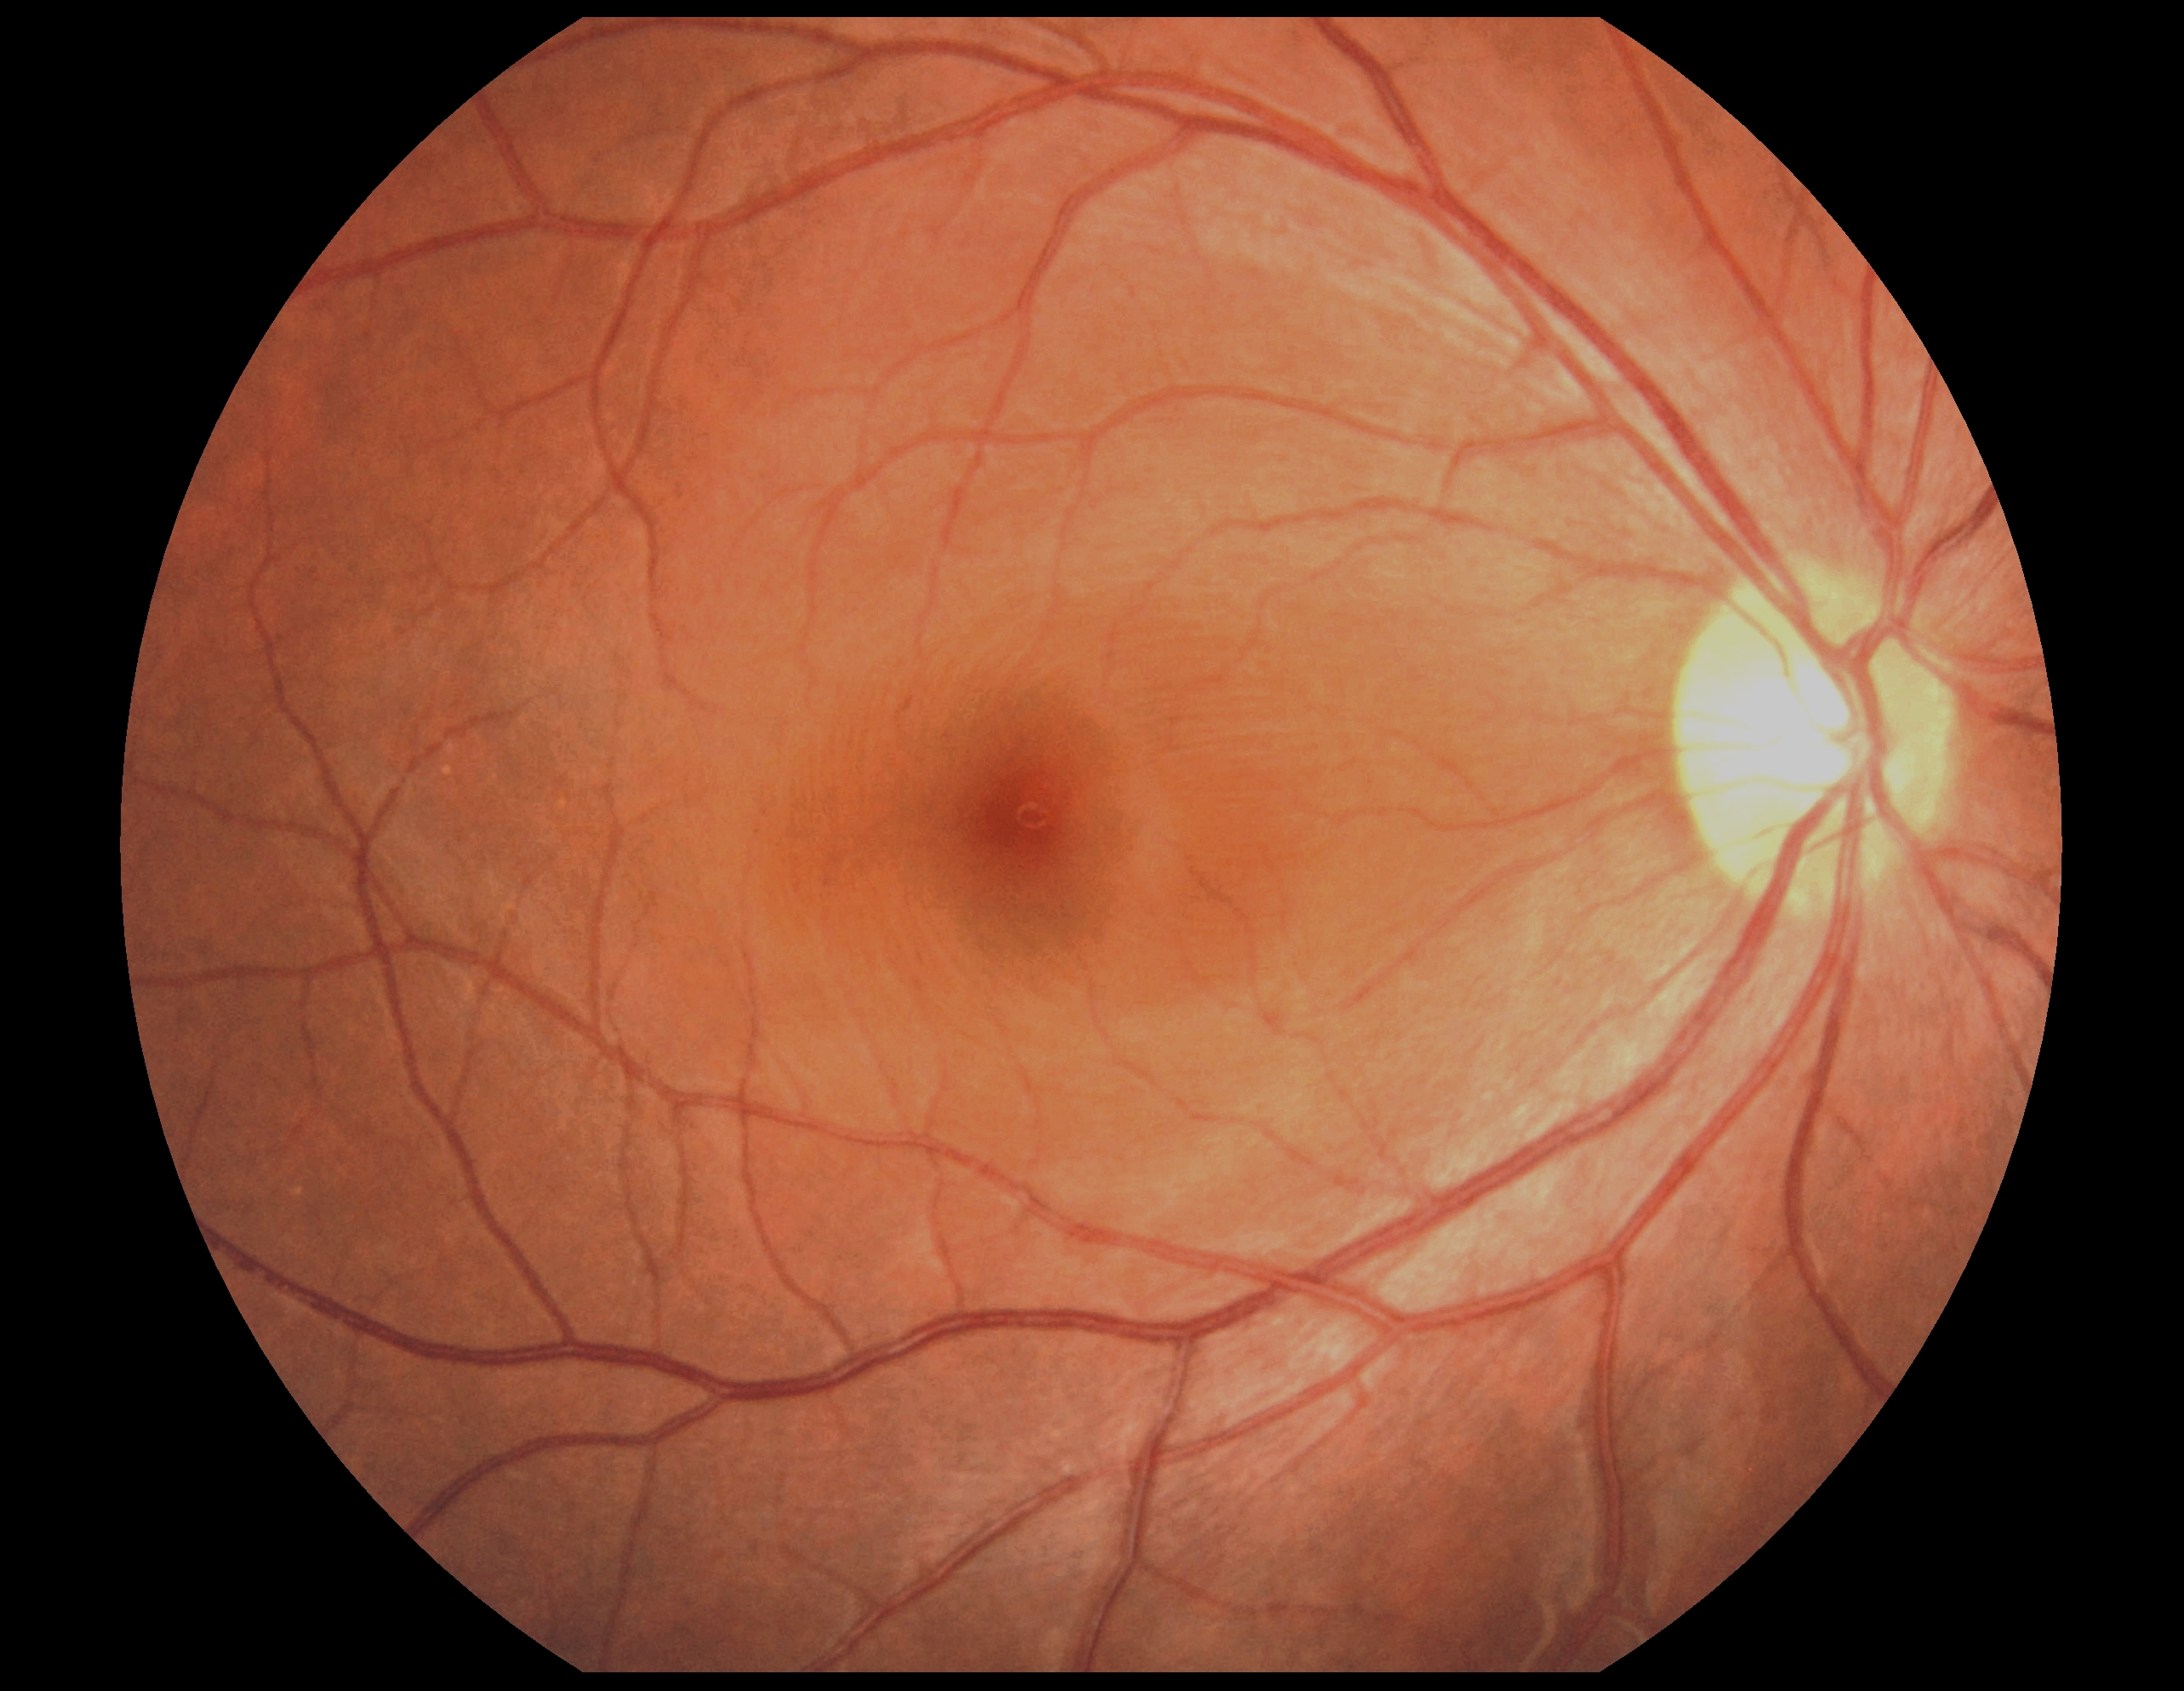 Diabetic retinopathy grade: 0. No DR findings.